Infant wide-field fundus photograph. 640x480px: 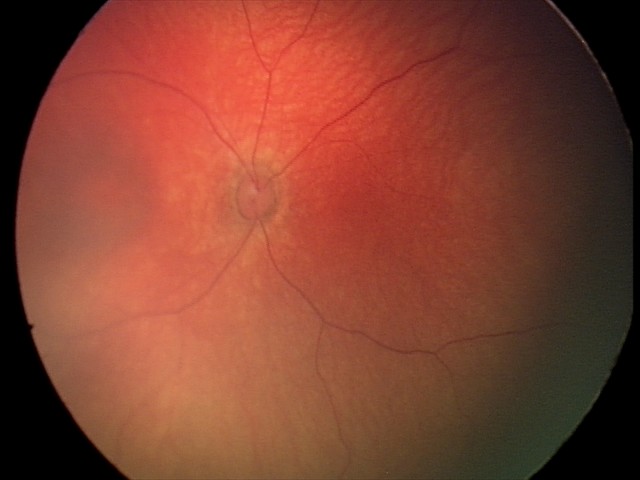

From an examination with diagnosis of retinal hemorrhages.